Fundus photo.
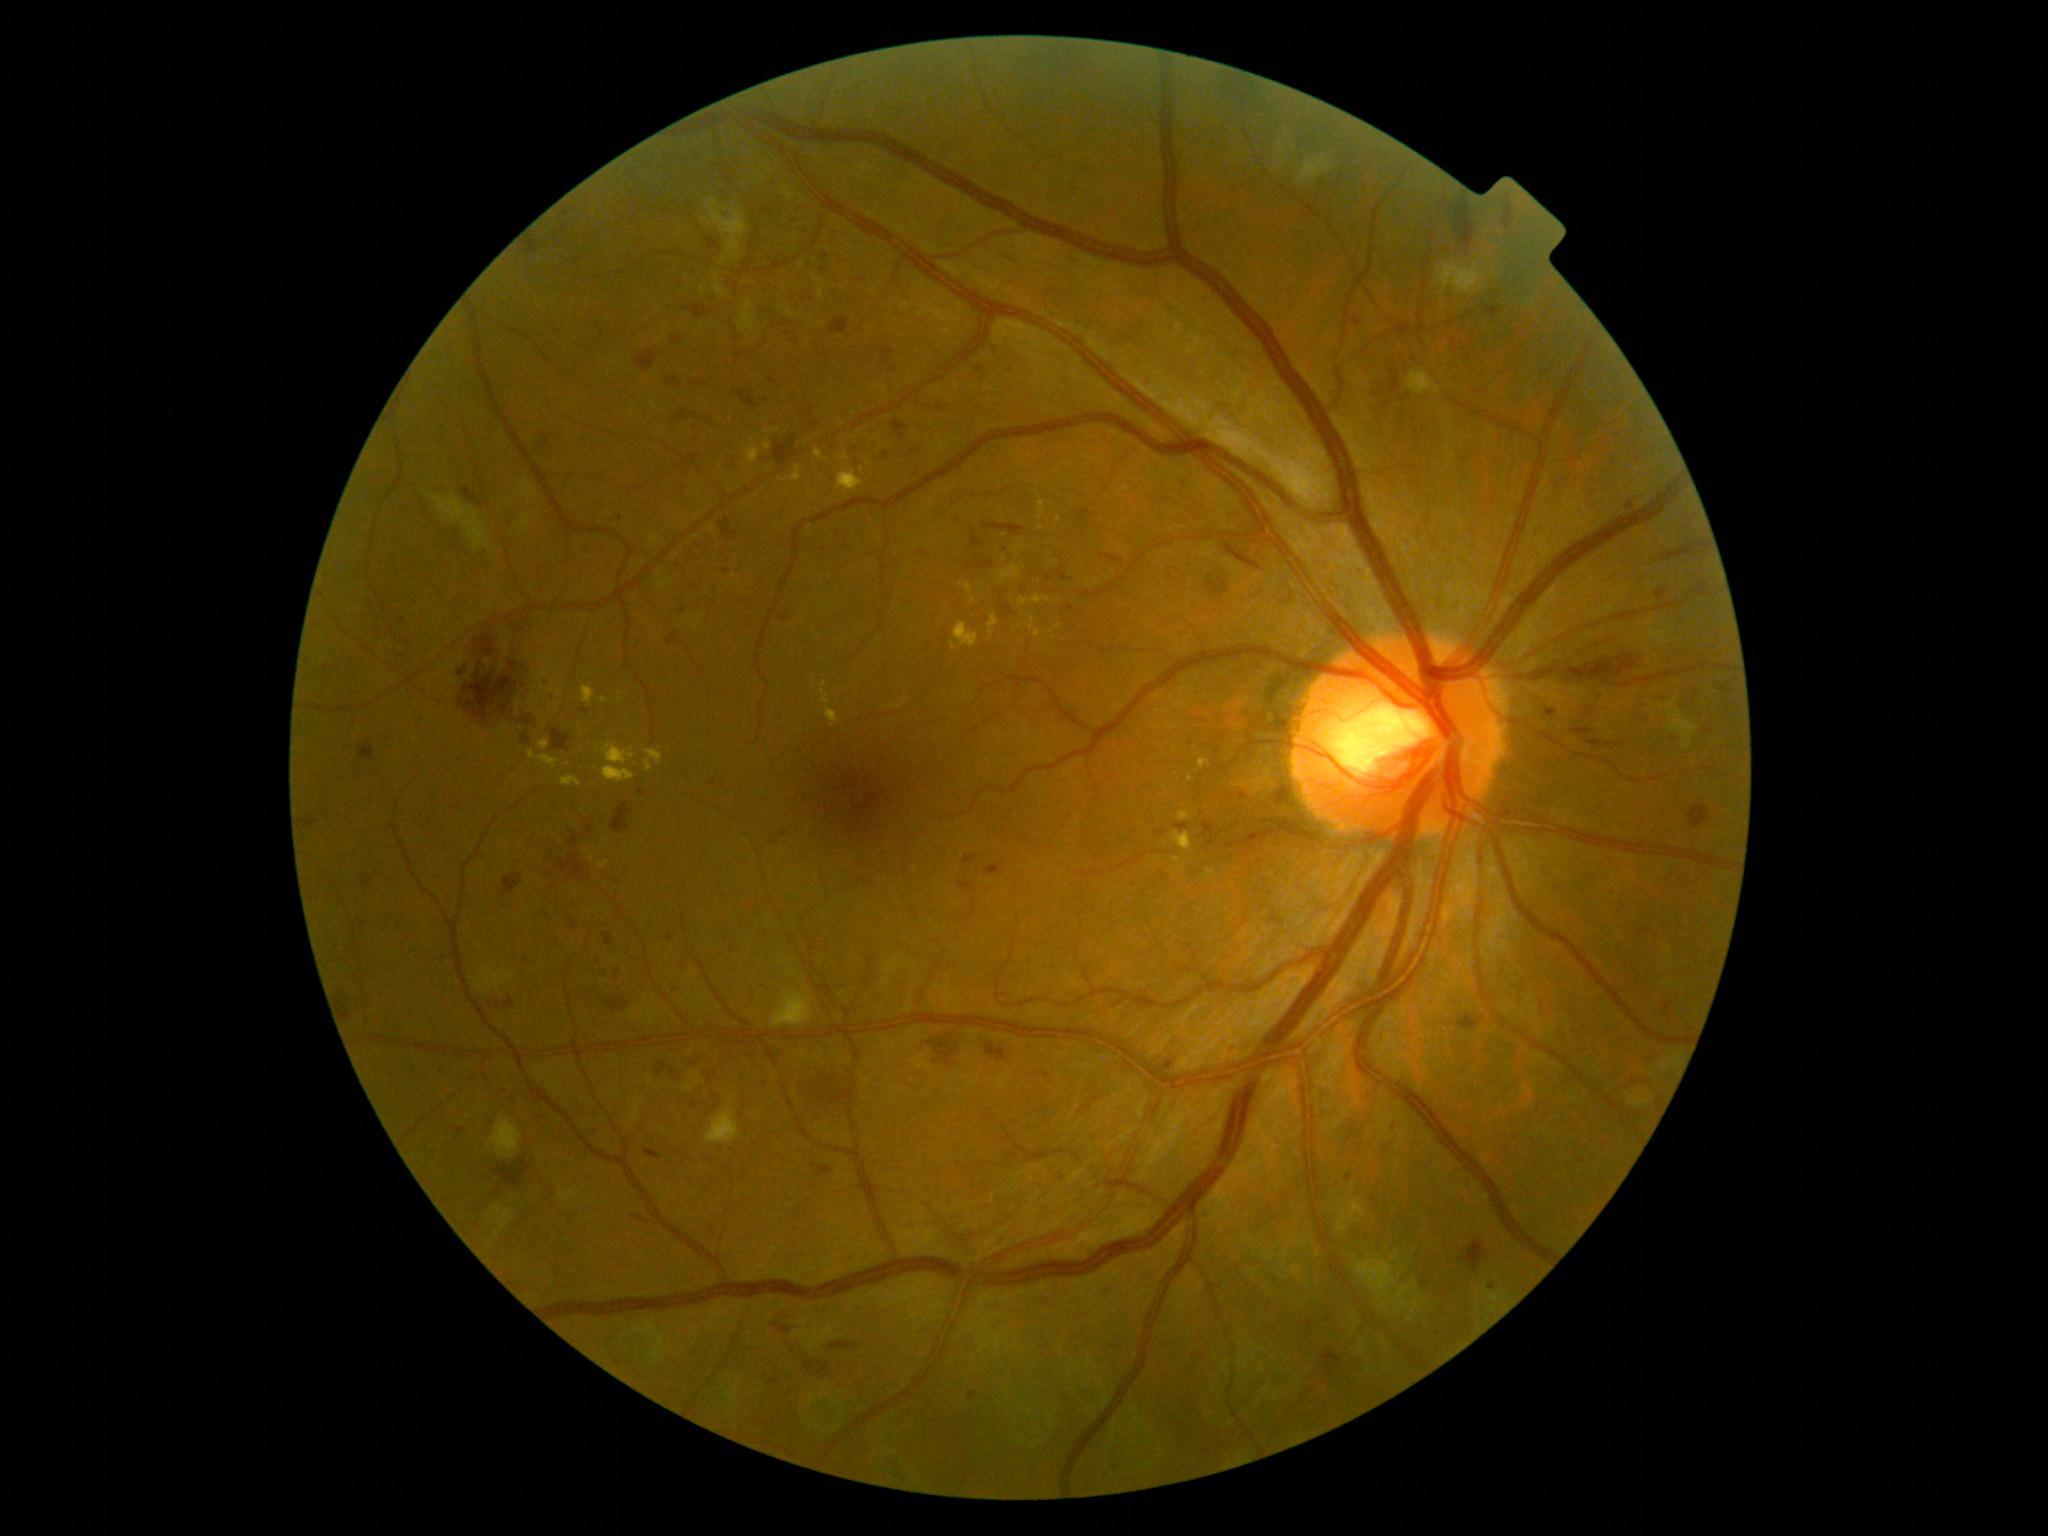 Disease class: non-proliferative diabetic retinopathy. Diabetic retinopathy grade is 3.